NIDEK AFC-230; no pharmacologic dilation — 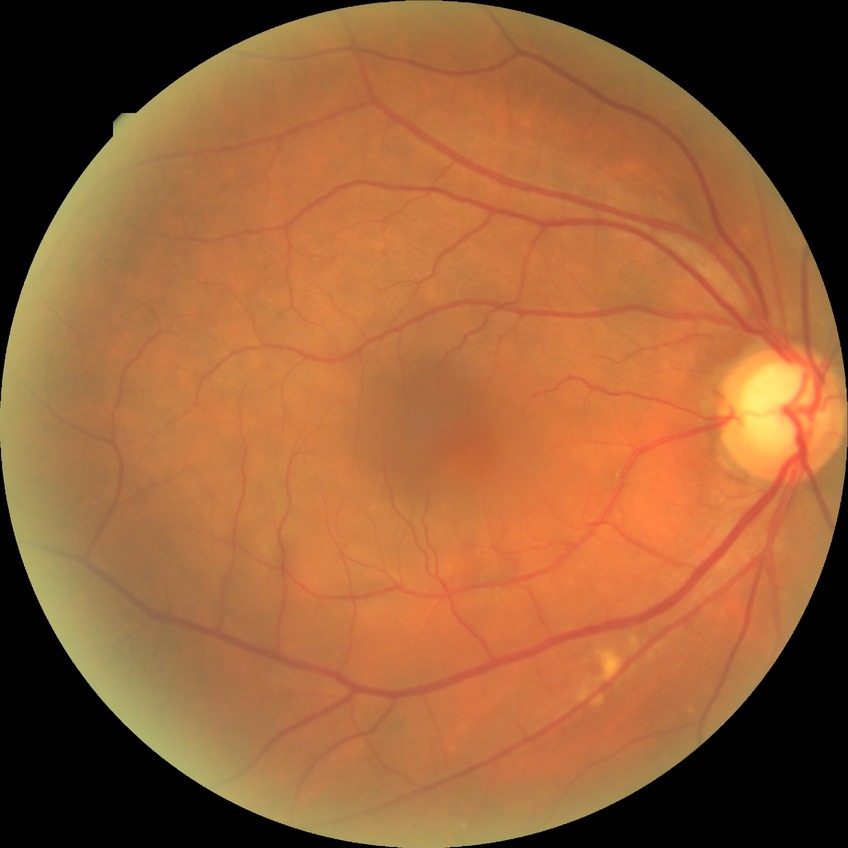

diabetic retinopathy (DR): no diabetic retinopathy (NDR).